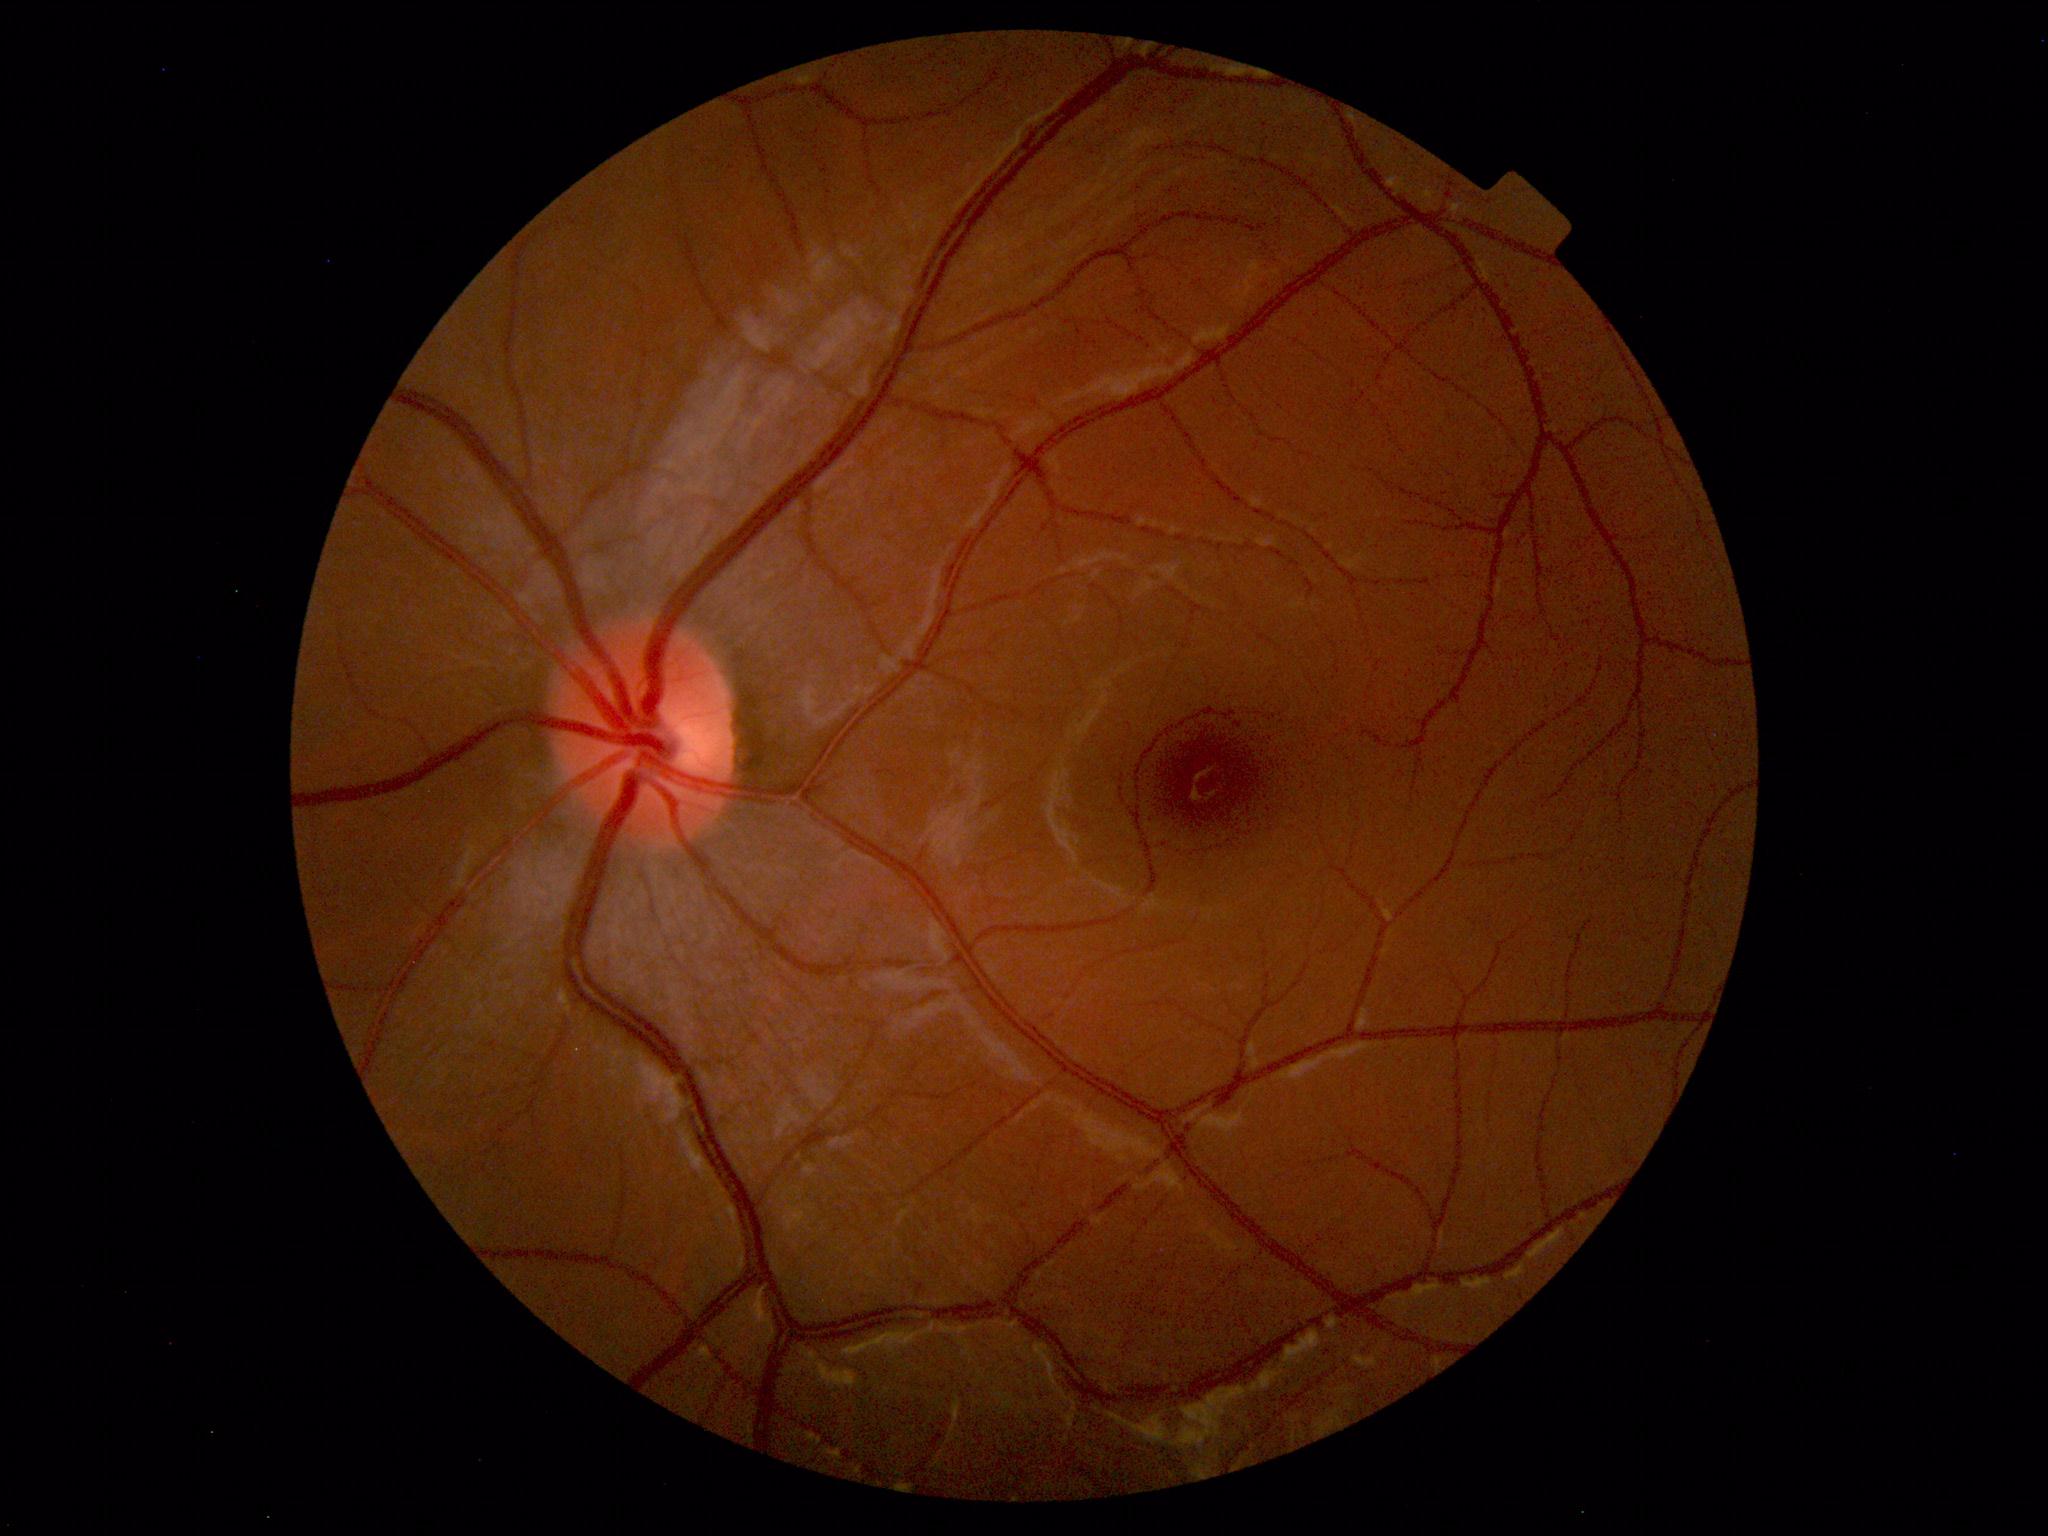 Findings: no abnormalities.